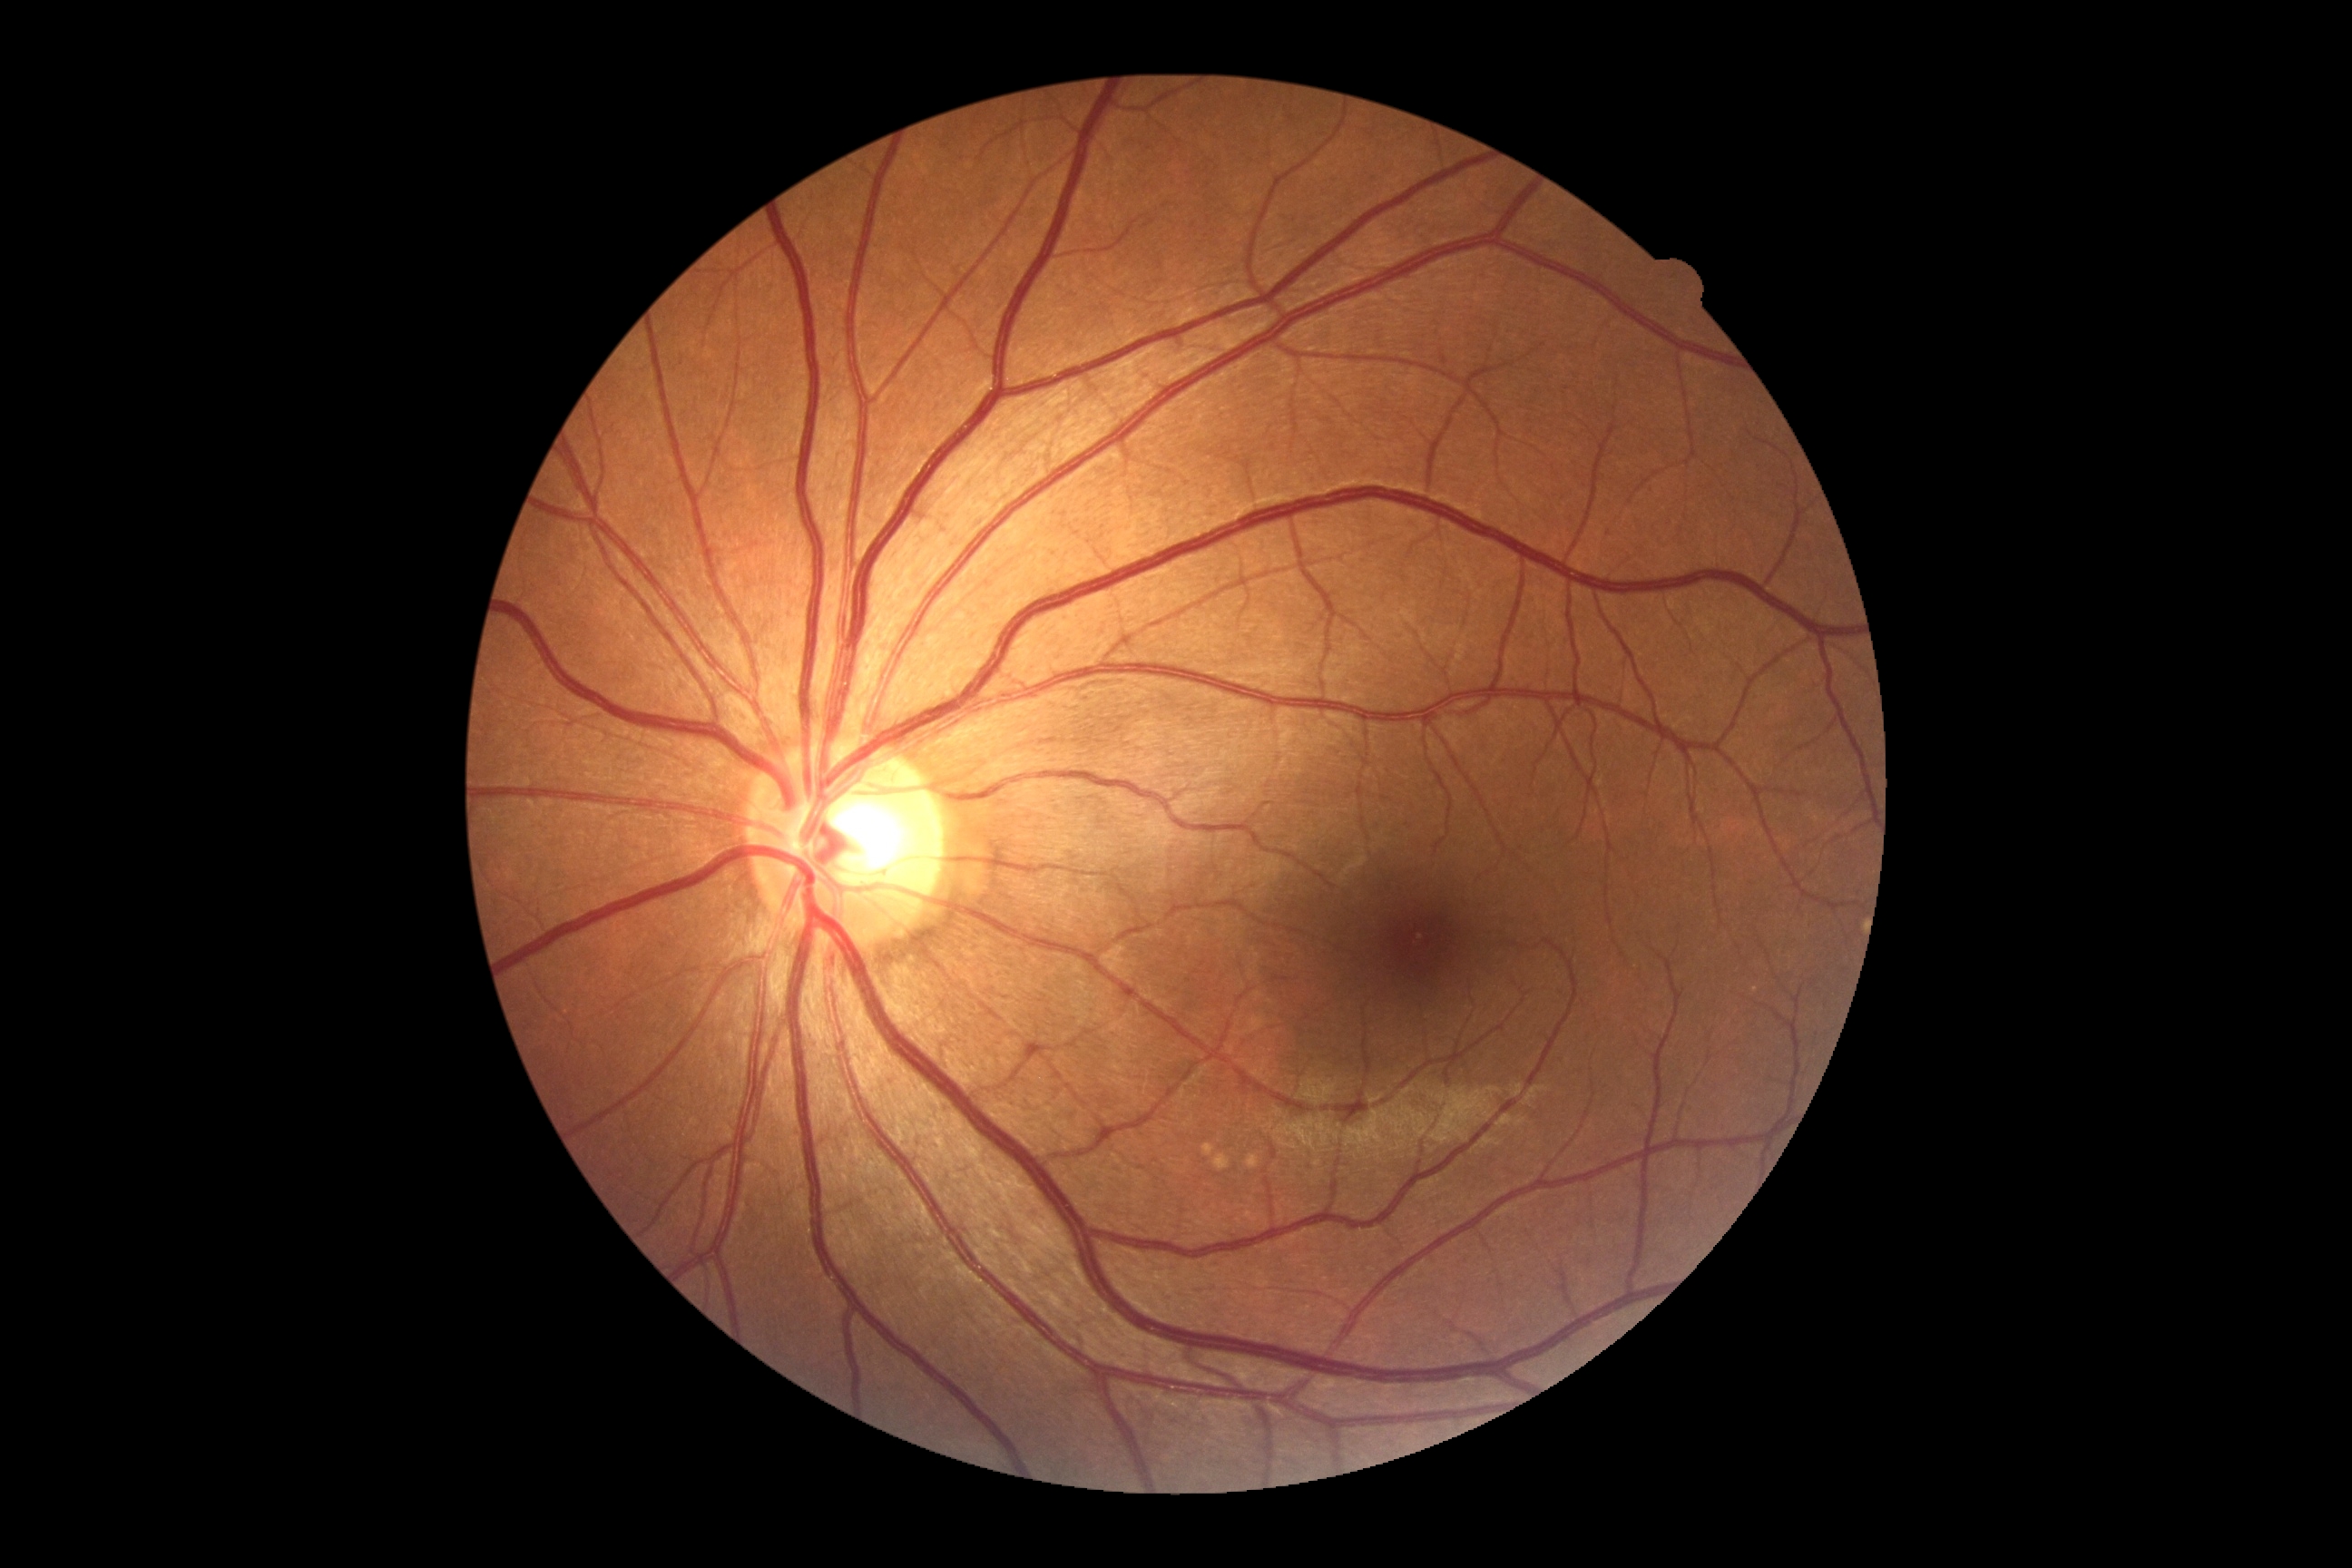 {"dr_impression": "no apparent DR", "dr_grade": "0/4 — no visible signs of diabetic retinopathy"}